Fundus photo · 2102x1736.
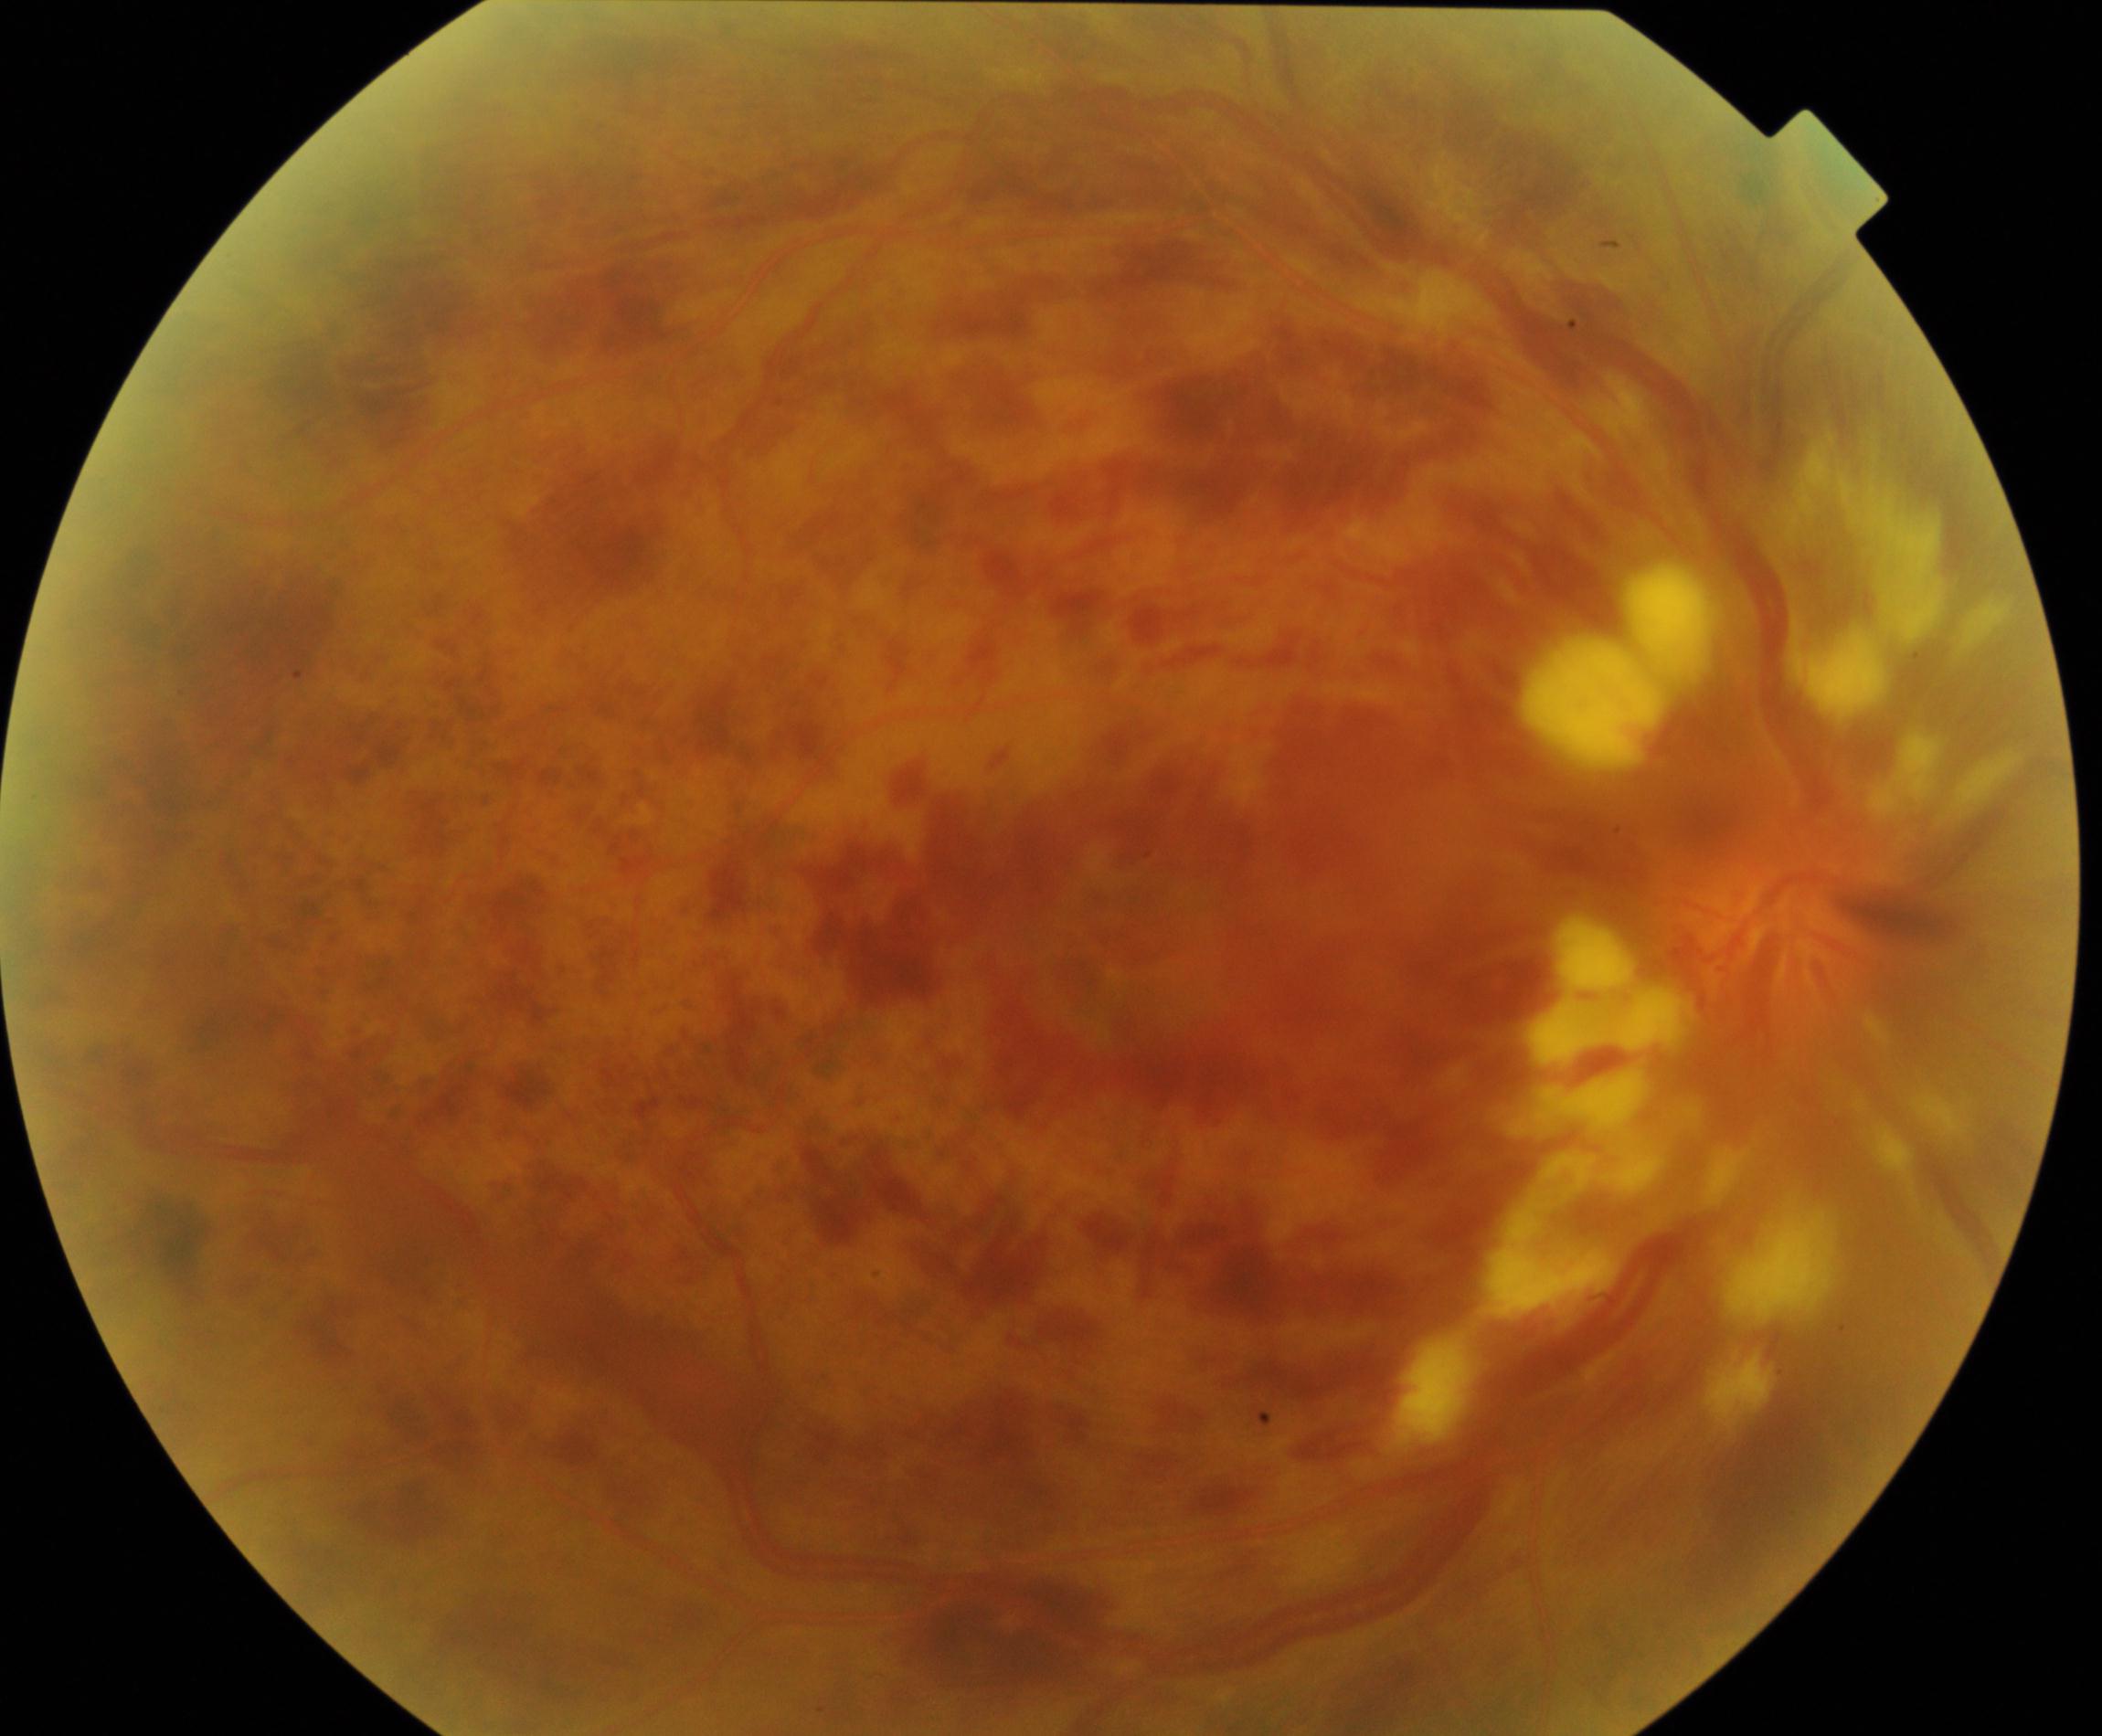 Diagnosis: central retinal vein occlusion (CRVO).